RetCam wide-field infant fundus image · camera: Clarity RetCam 3 (130° FOV) · 640x480px: 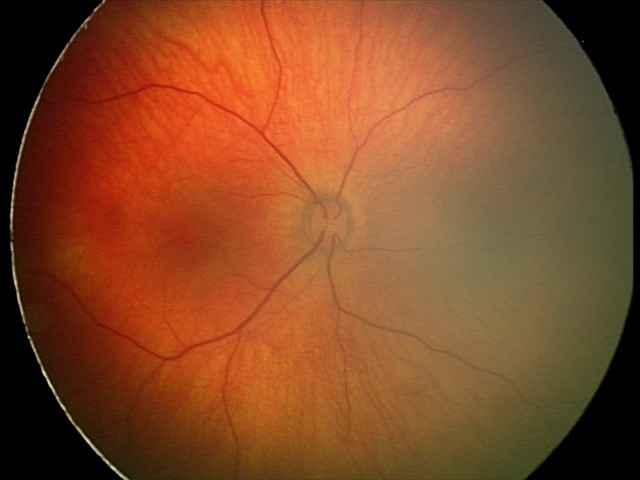 Examination diagnosed as retinal hemorrhages.